Non-mydriatic; 240x240 — 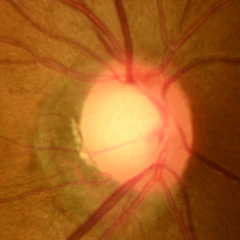 Optic disc photograph demonstrating no glaucomatous changes.